Graded on the modified Davis scale — 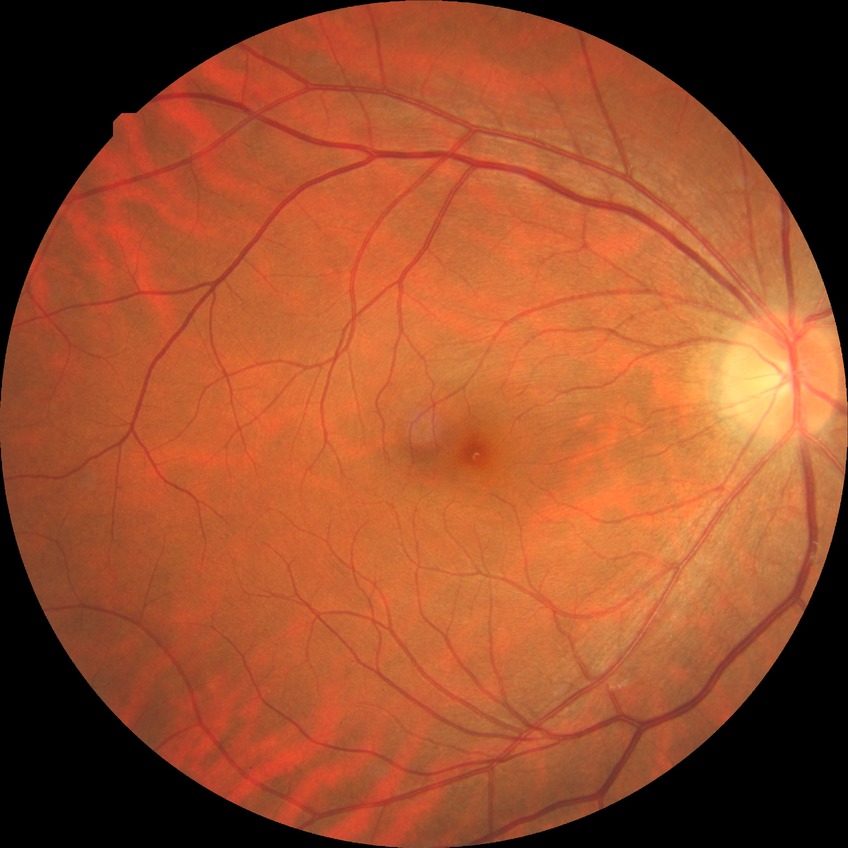
Findings:
• diabetic retinopathy (DR) — NDR (no diabetic retinopathy)